CFP.
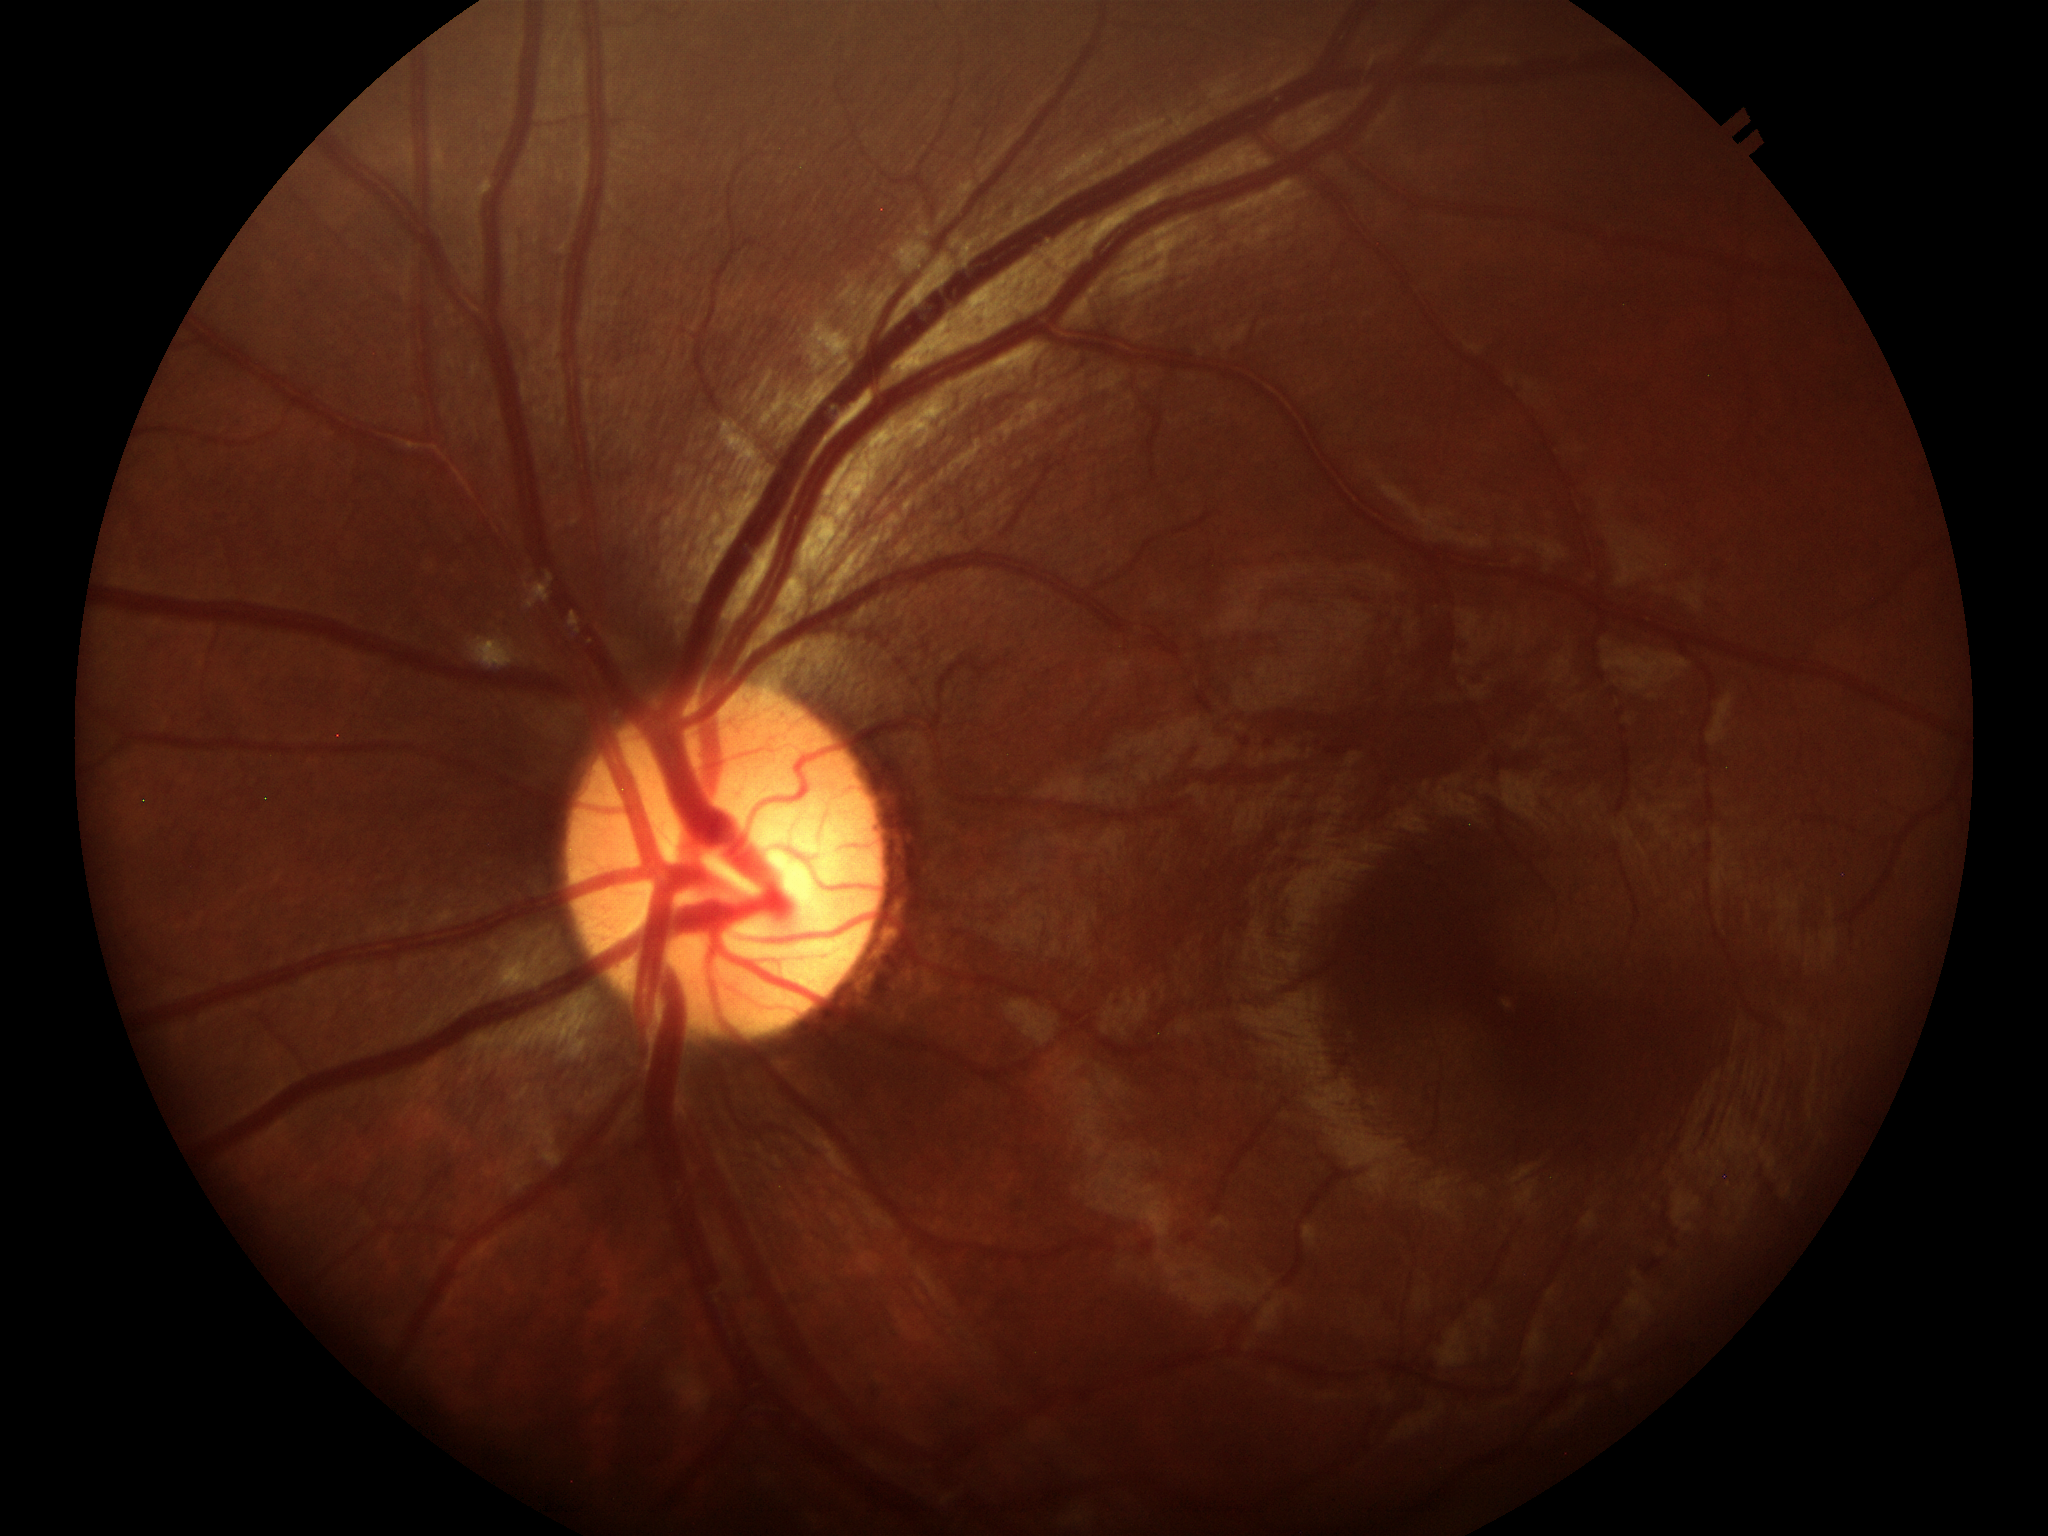

Annotations:
* Glaucoma screening impression — not suspect (5/5 ophthalmologists in agreement)
* VCDR — 0.47
* ACDR — 0.23